Color fundus image · NIDEK AFC-230 · Davis DR grading — 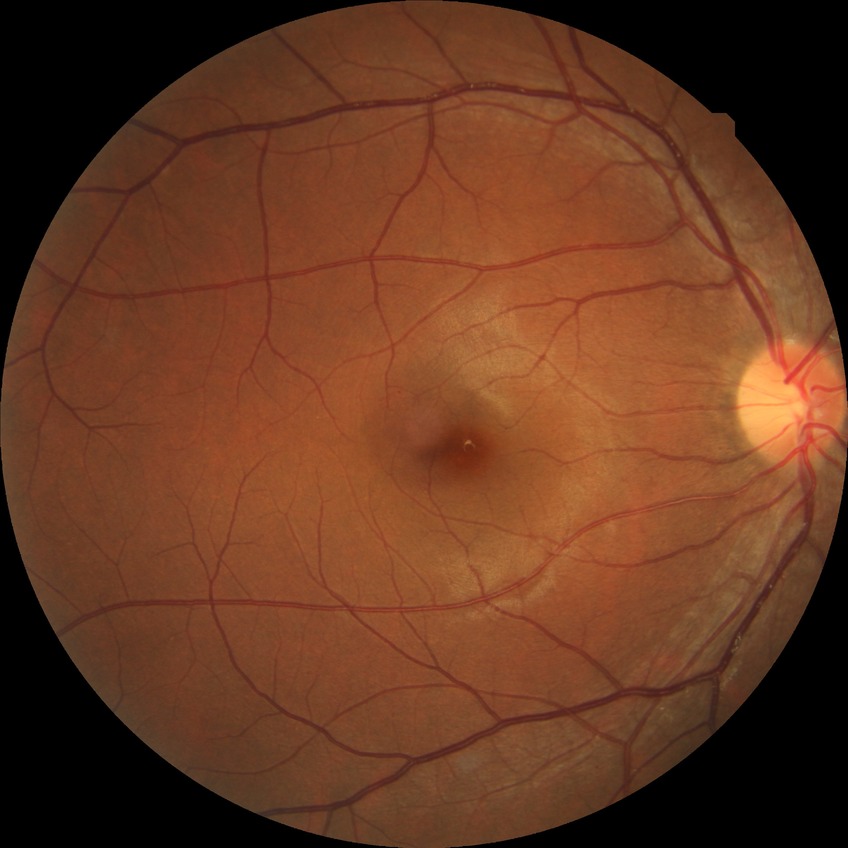 Diabetic retinopathy stage is no diabetic retinopathy.